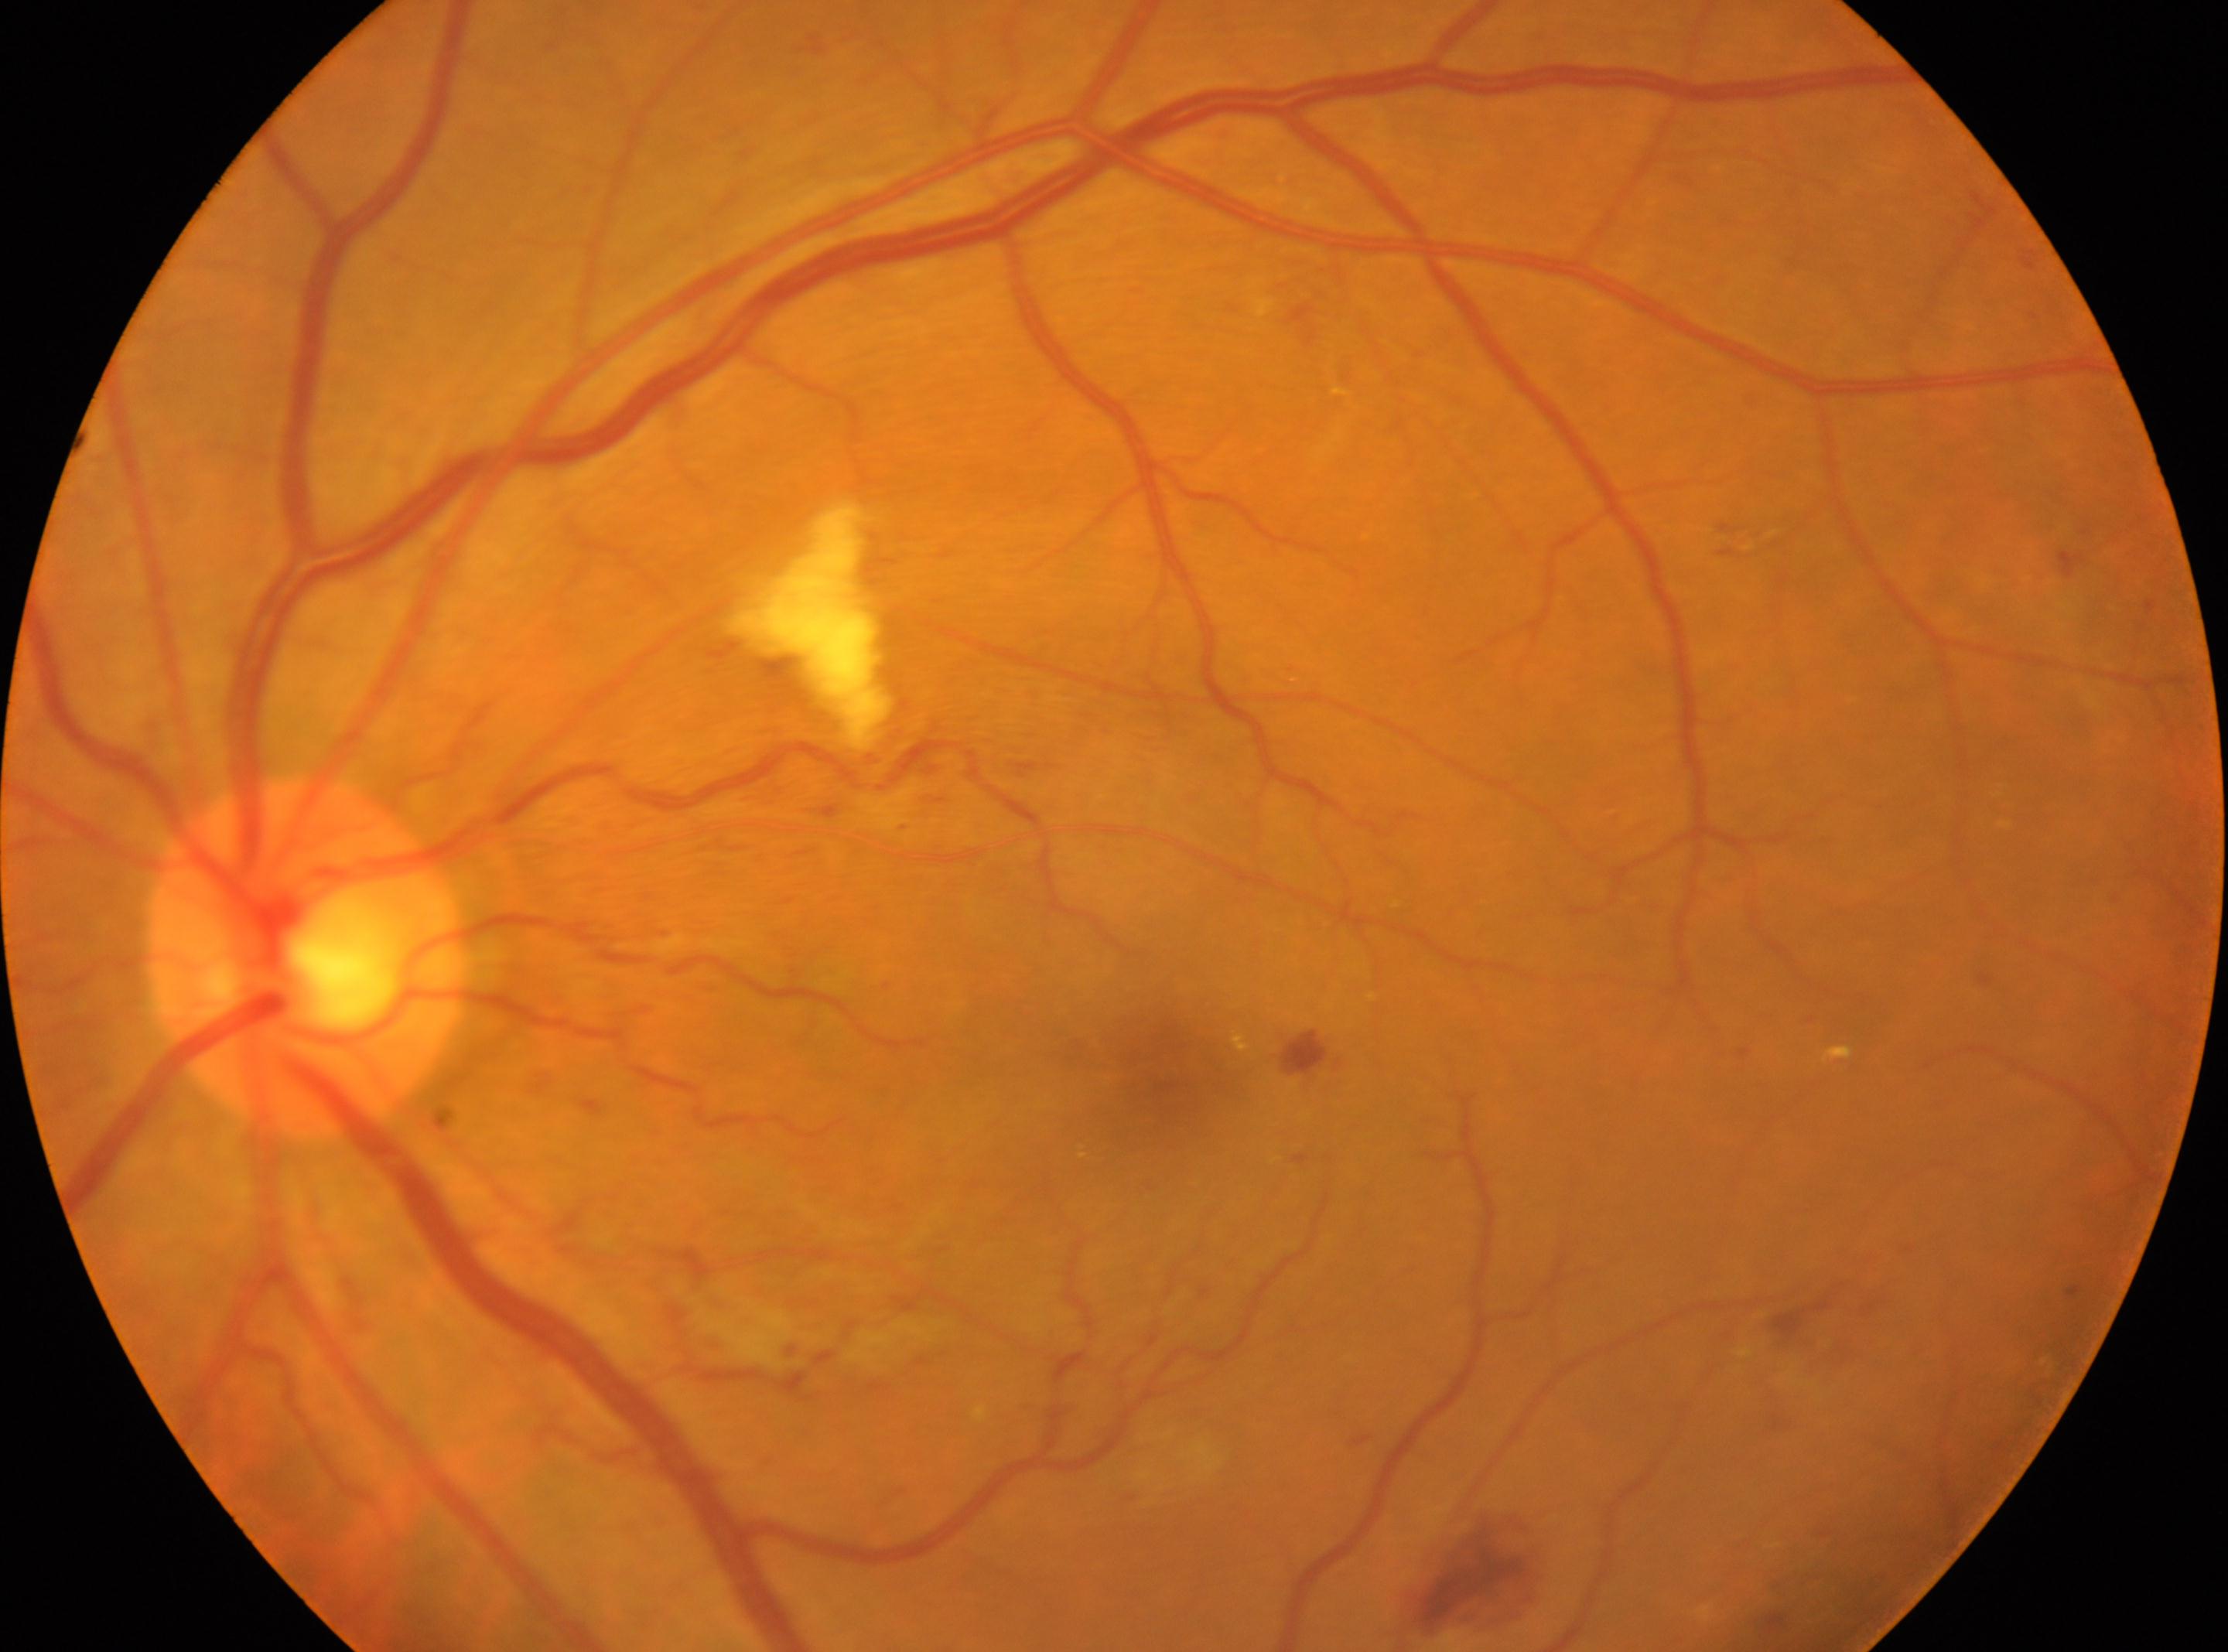 DR class: non-proliferative diabetic retinopathy.
Diabetic retinopathy severity: 2.
Optic disc: (x: 308, y: 959).
Fovea center: (x: 1156, y: 1073).
Imaged eye: OS.